848 by 848 pixels; 45-degree field of view — 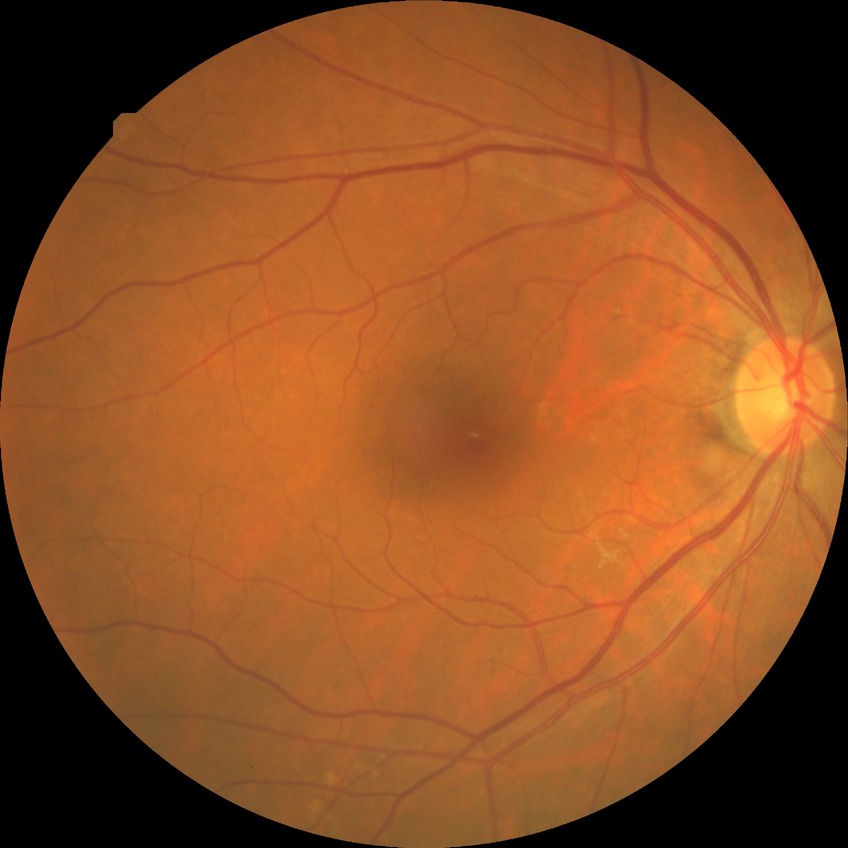
Modified Davis classification: simple diabetic retinopathy.